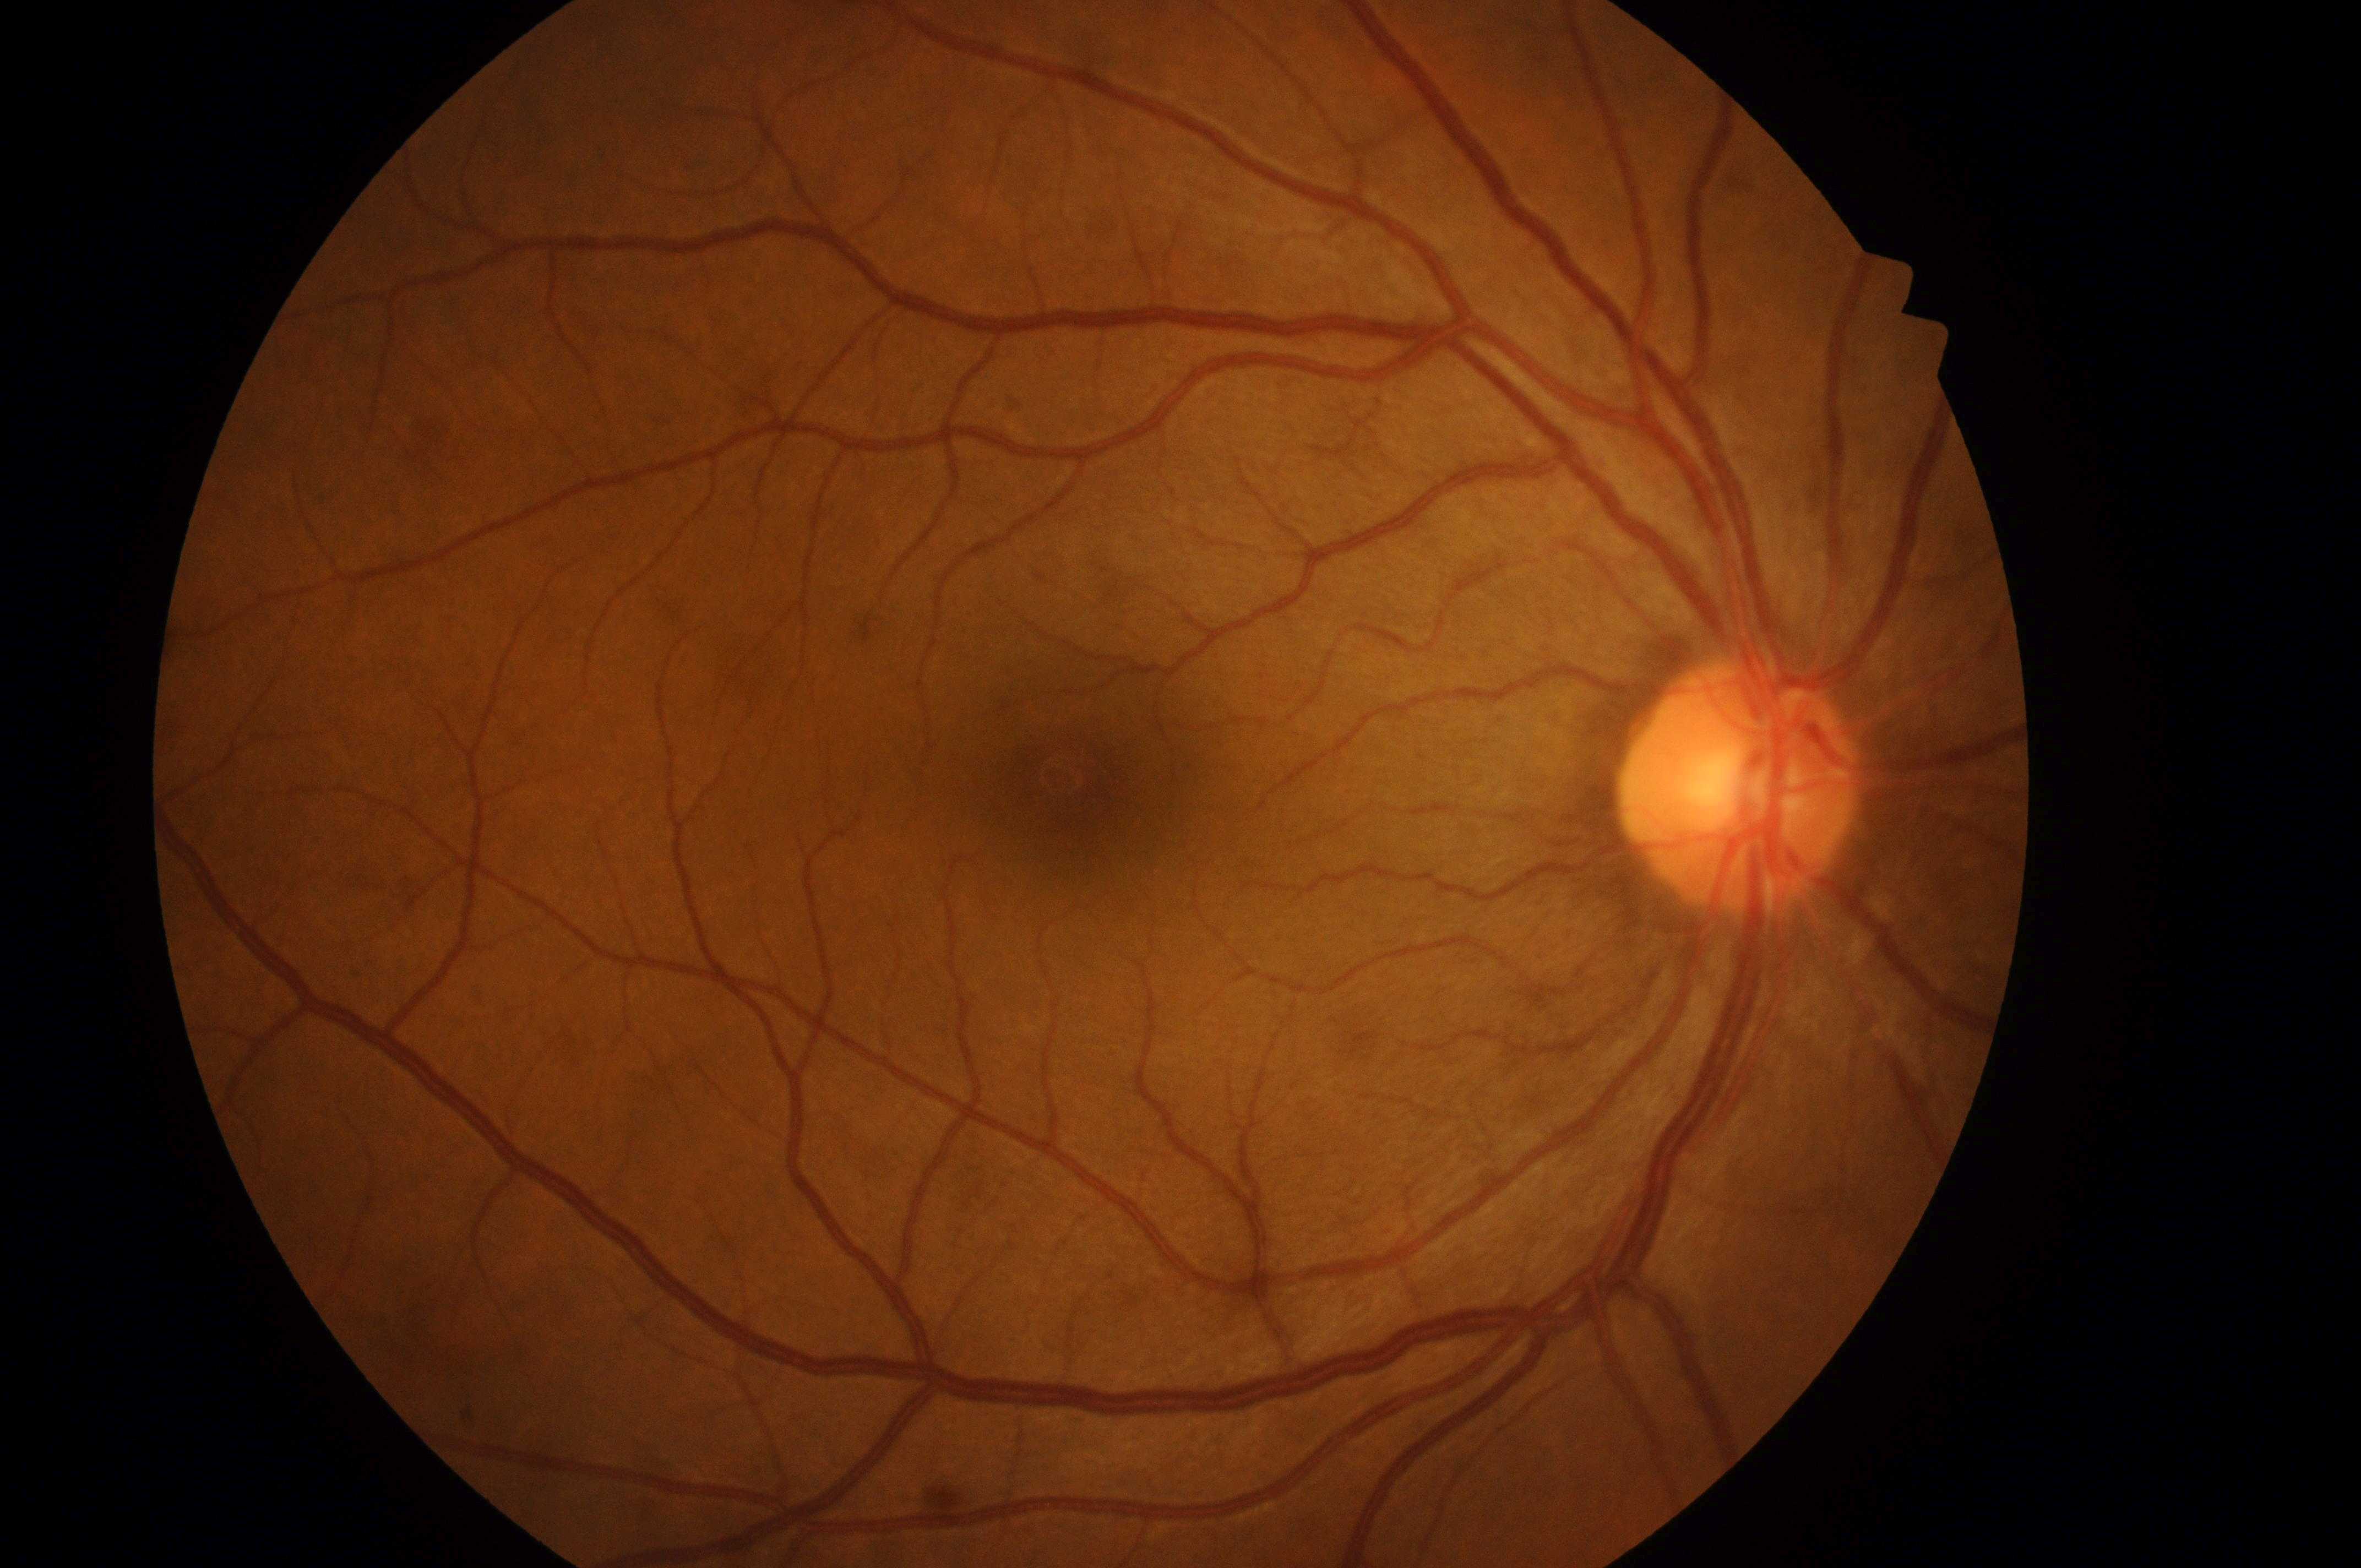

Foveal center located at [1079, 787].
Diabetic retinopathy severity is grade 0 (no apparent retinopathy).
The disc center is at [1735, 793].
Imaged eye: right eye.
Macular edema is grade 0 (no risk).
No diabetic retinopathy; no macular edema risk.